CFP, 45-degree field of view: 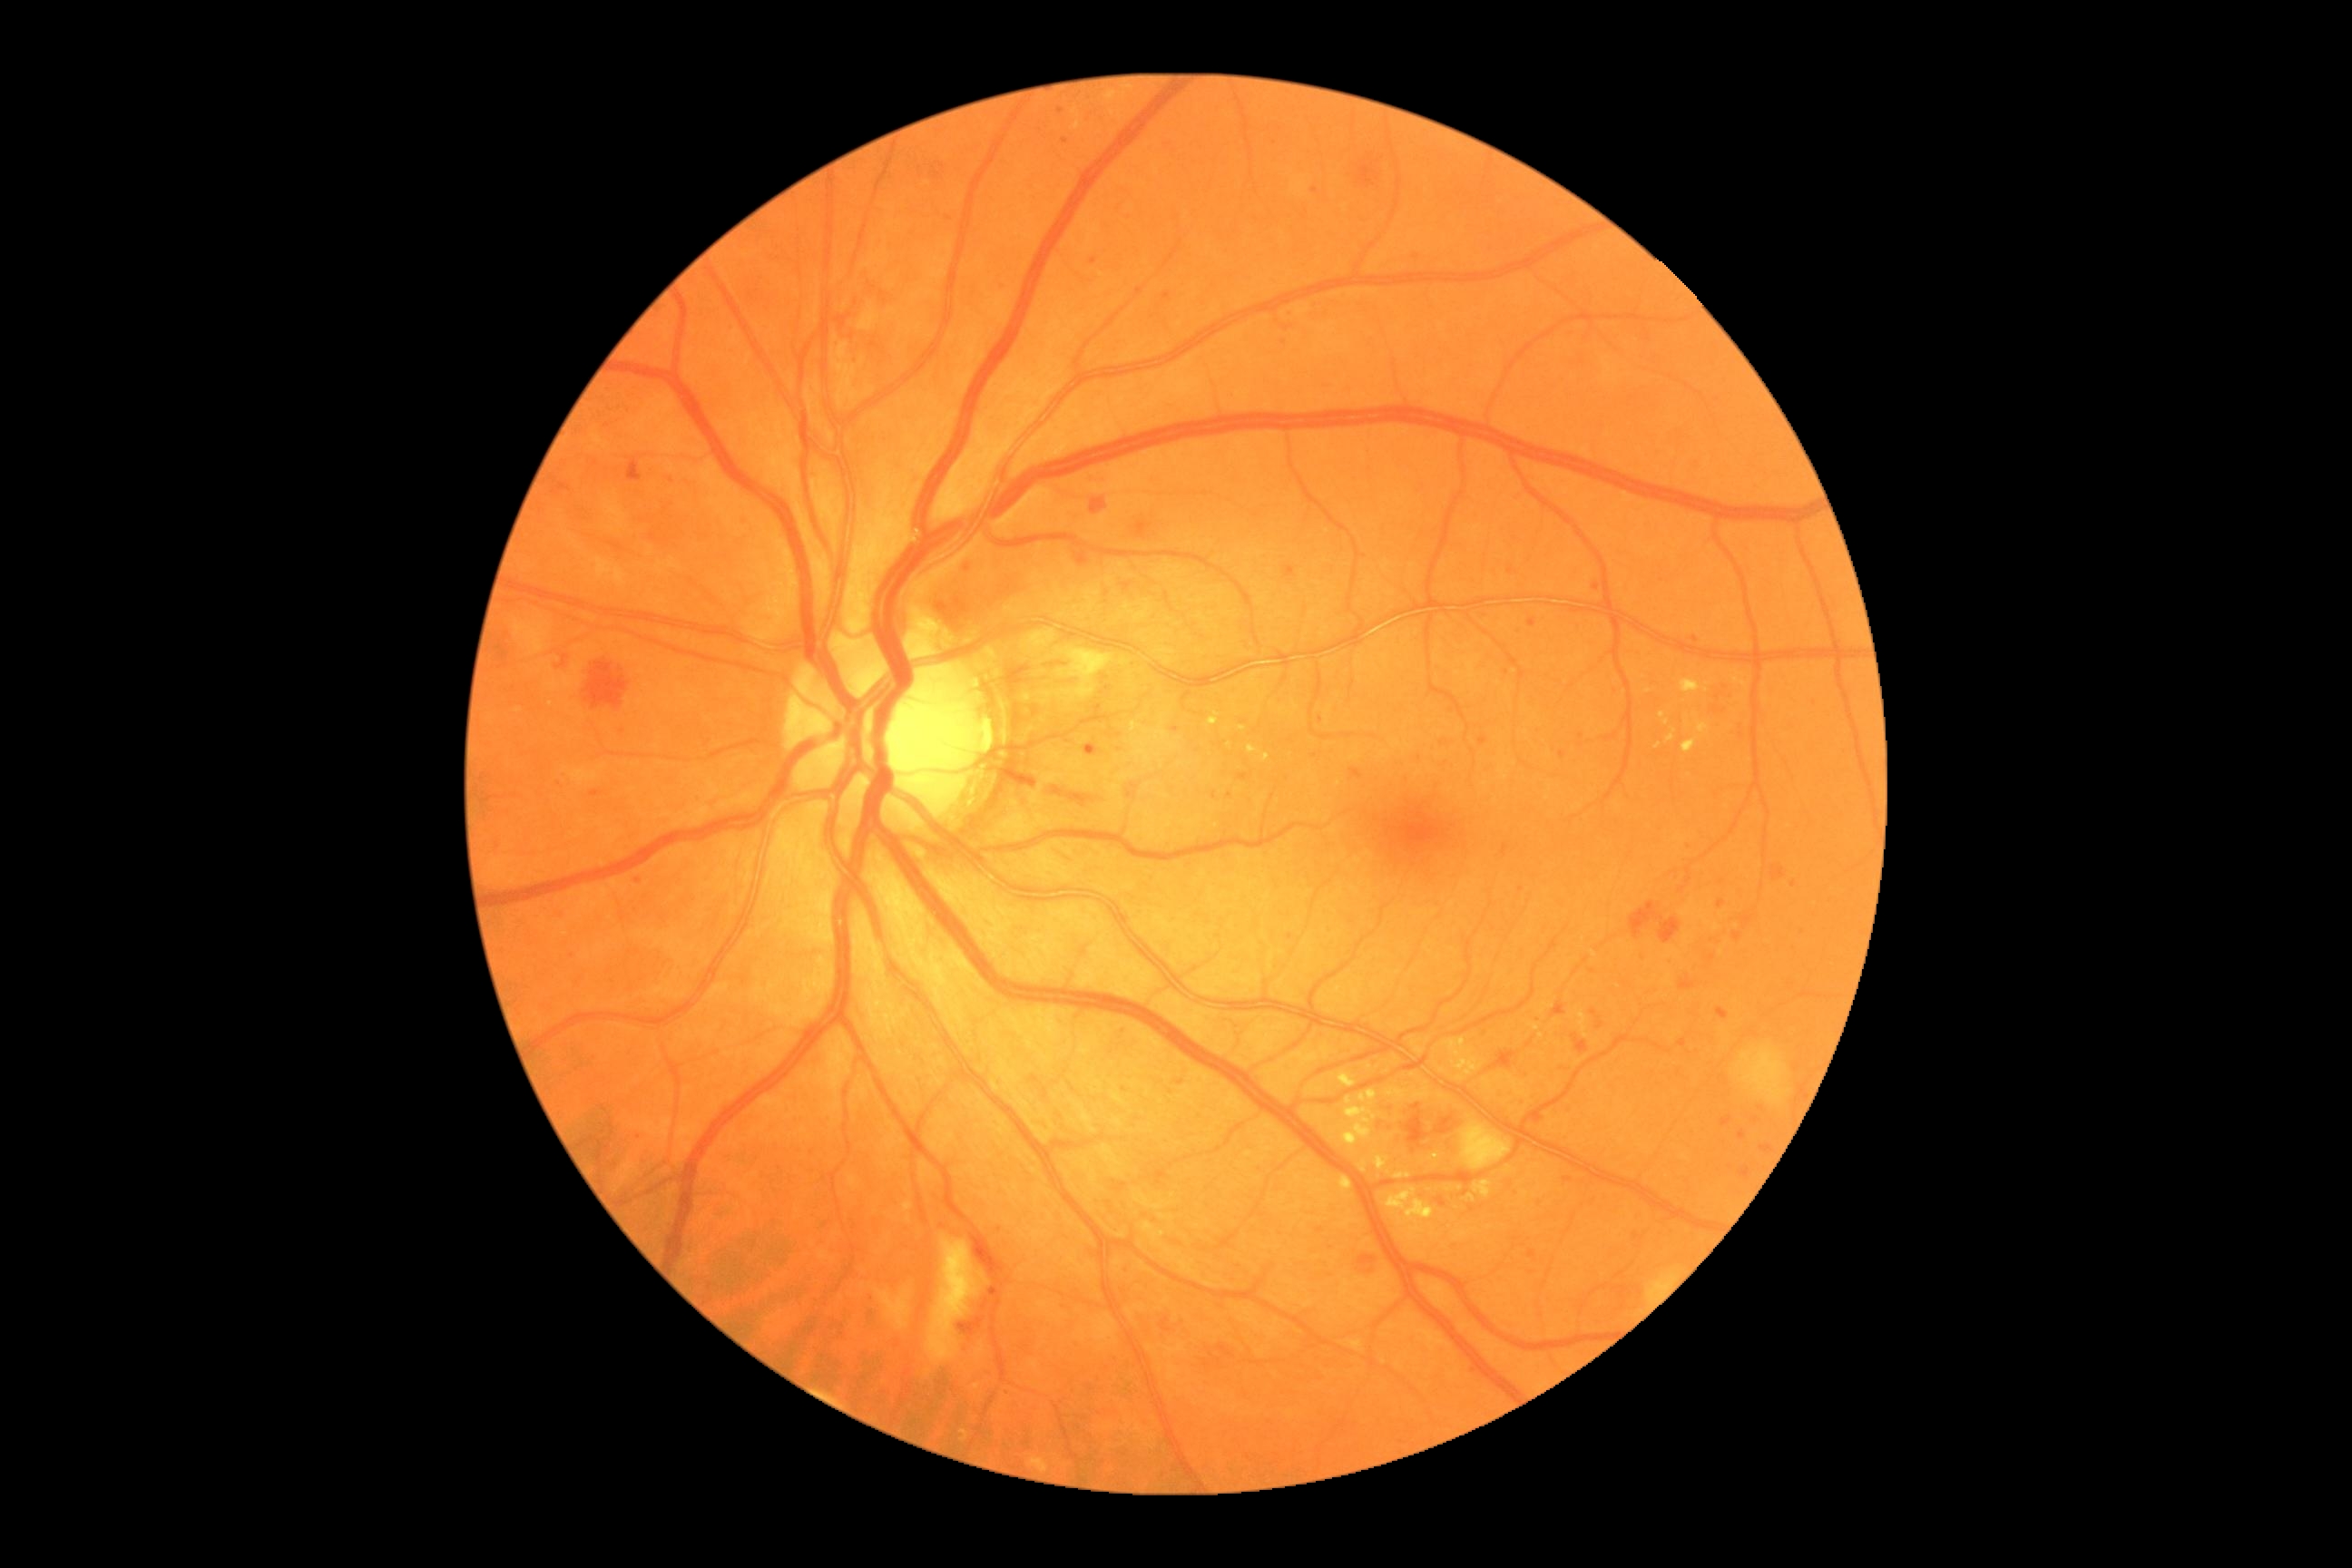

<lesions partial="true">
  <dr_grade>3</dr_grade>
  <ex partial="true">1248,745,1259,754; 1342,1090,1382,1148; 1680,680,1701,694; 1386,1190,1416,1210; 1072,651,1106,672; 1360,1162,1367,1173; 1475,1181,1493,1199; 1732,672,1749,691; 1683,738,1700,754; 1660,712,1671,727; 1395,1173,1411,1179; 1202,716,1213,727; 1239,727,1248,732</ex>
  <ex_small>1648:692; 1707:690; 1658:746; 1432:1158</ex_small>
  <se>858,306,879,331; 926,1235,981,1366; 876,1289,910,1331; 514,620,549,656; 1738,1046,1790,1106; 1460,1121,1511,1171</se>
  <he partial="true">974,1239,985,1262; 963,562,975,573; 992,769,1034,787; 1553,1003,1567,1017; 1351,769,1362,779; 556,654,569,669; 1721,1117,1732,1126; 1090,496,1106,514; 1044,789,1101,810; 583,660,629,710; 1438,1197,1446,1208; 1716,1008,1729,1021; 1435,1117,1458,1135; 1355,1255,1377,1277; 1770,867,1787,881; 627,458,642,482; 1529,1251,1536,1260</he>
  <he_small>1683:1044; 1537:1118</he_small>
  <ma partial="true">1718,901,1727,910; 1560,750,1565,760; 1239,774,1248,781; 990,1286,1001,1298</ma>
  <ma_small>1717:710; 567:913; 623:732; 1066:141; 1167:296; 1121:1027; 966:1329; 1755:1121; 1366:556; 1479:1370; 1230:796; 1322:720; 1538:1021</ma_small>
</lesions>